Fundus photo
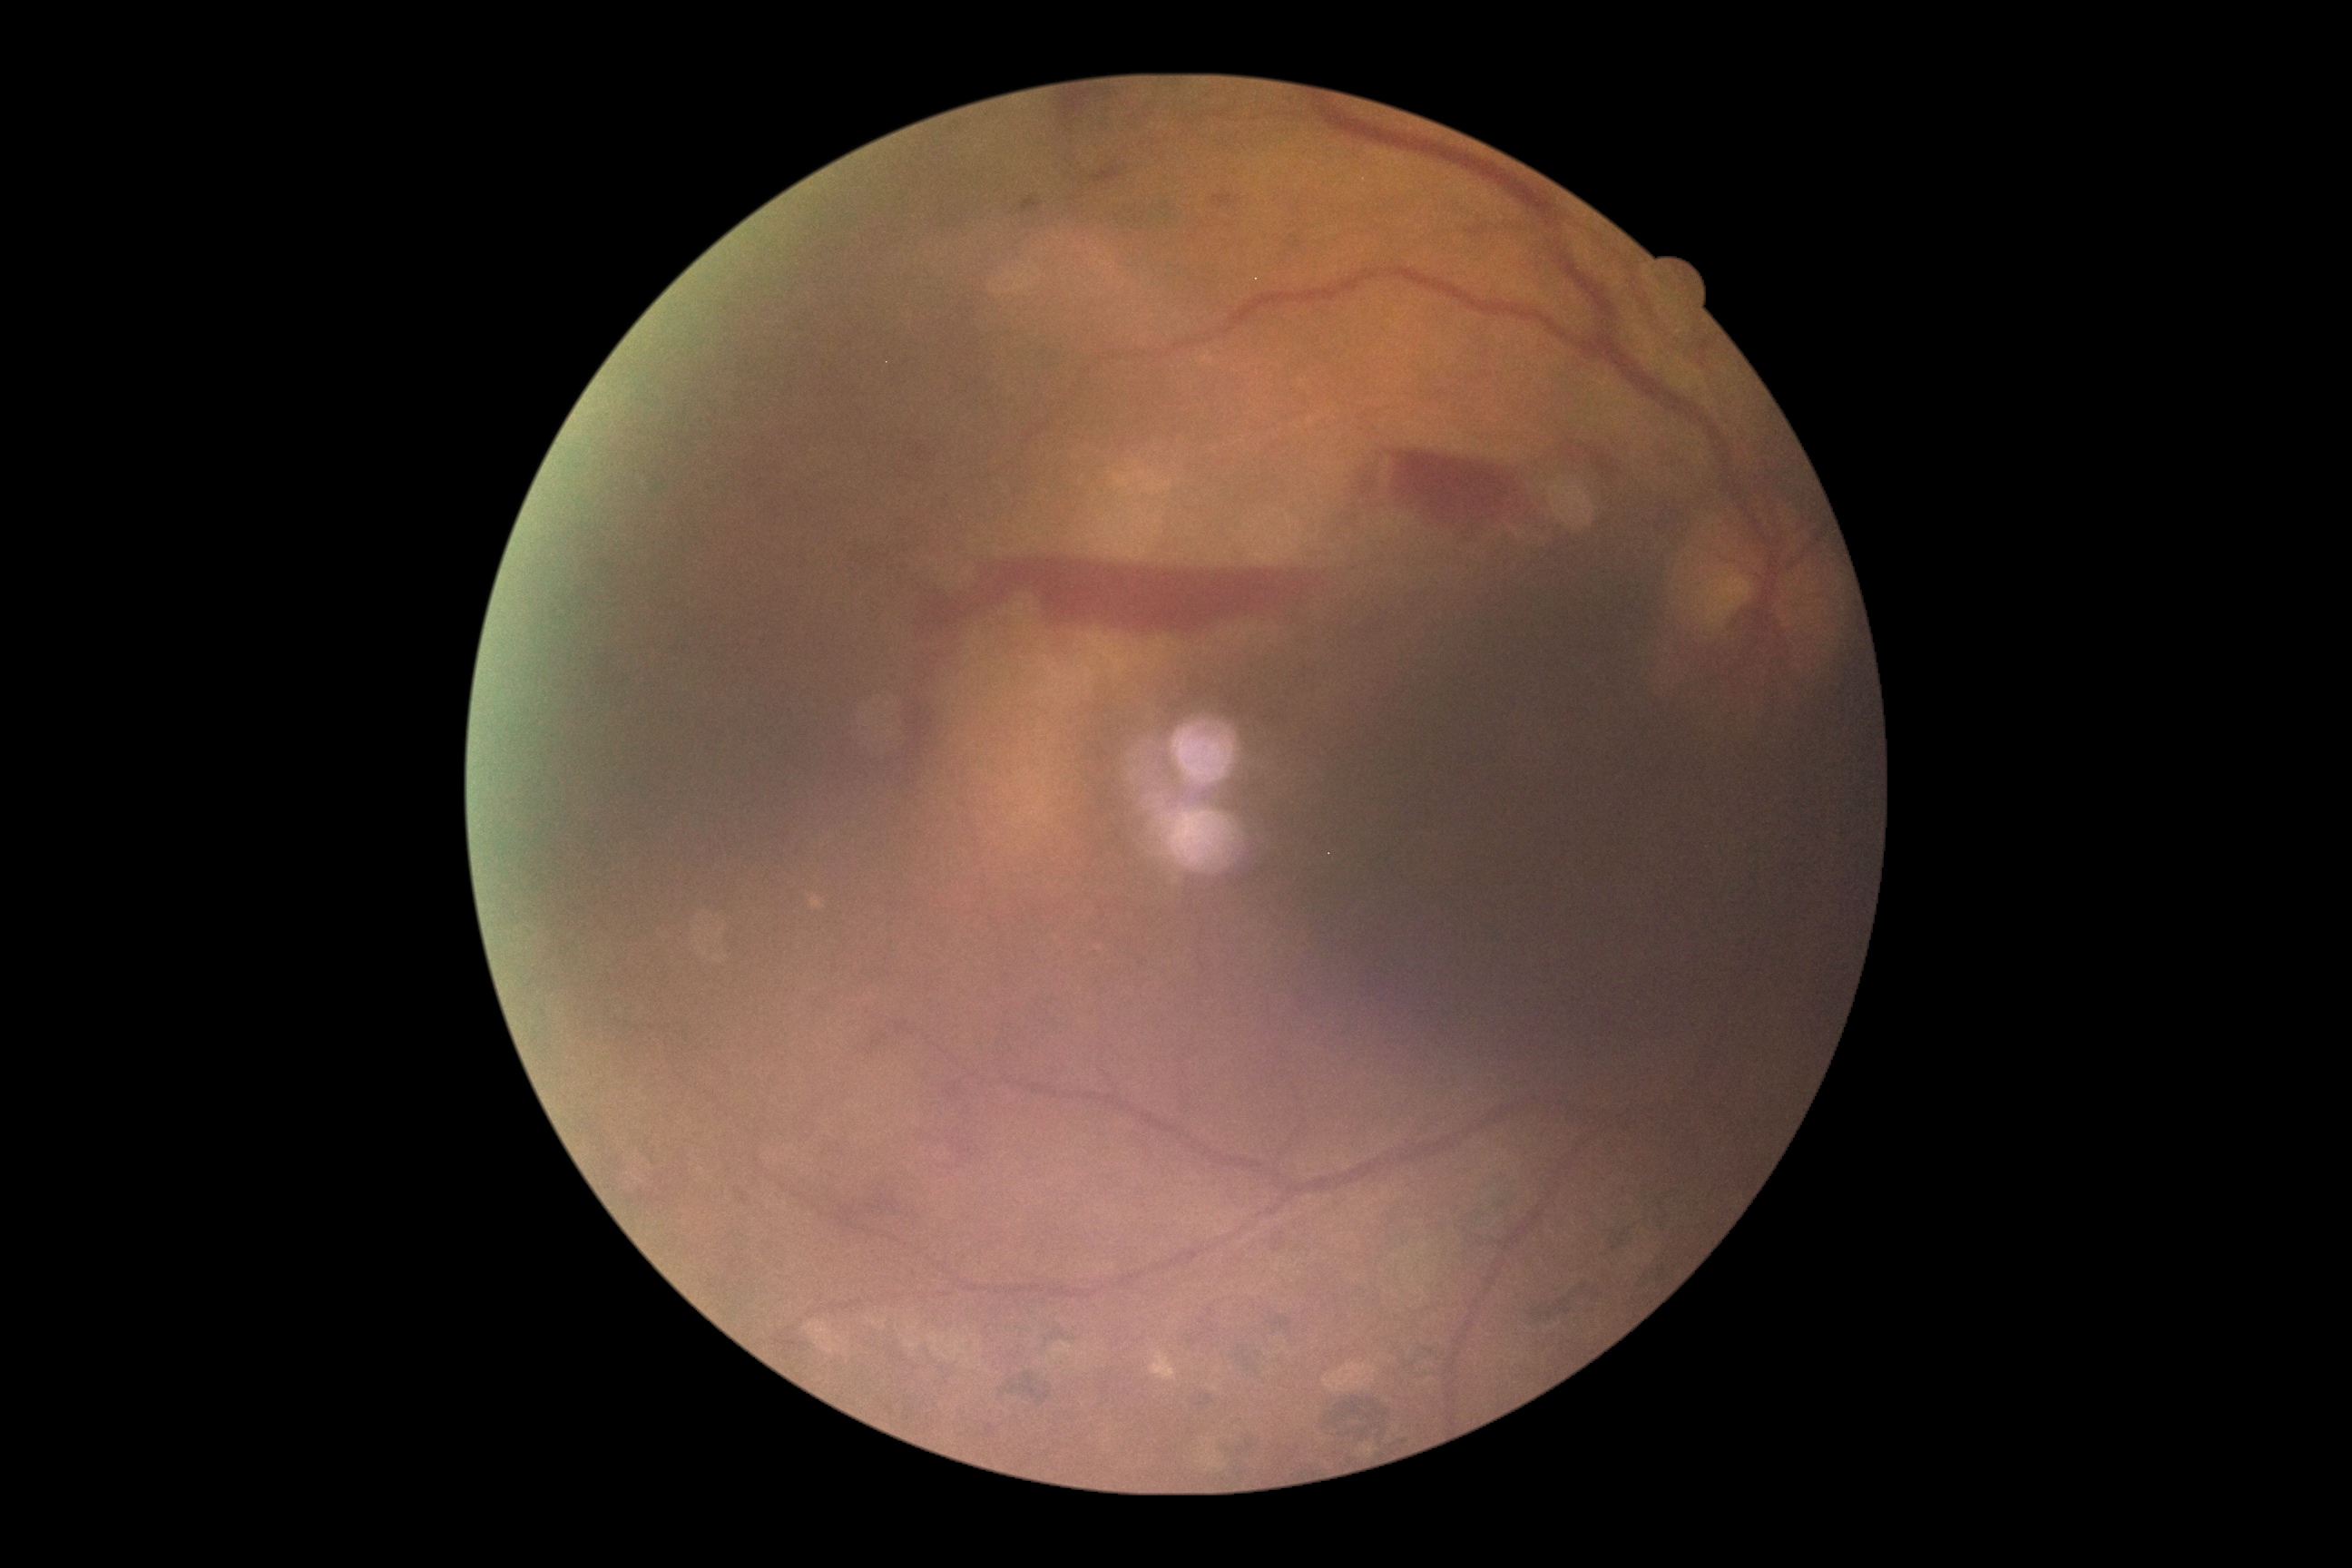

DR stage is grade 4 (PDR).